50° FOV; color fundus image; 1924 by 1556 pixels:
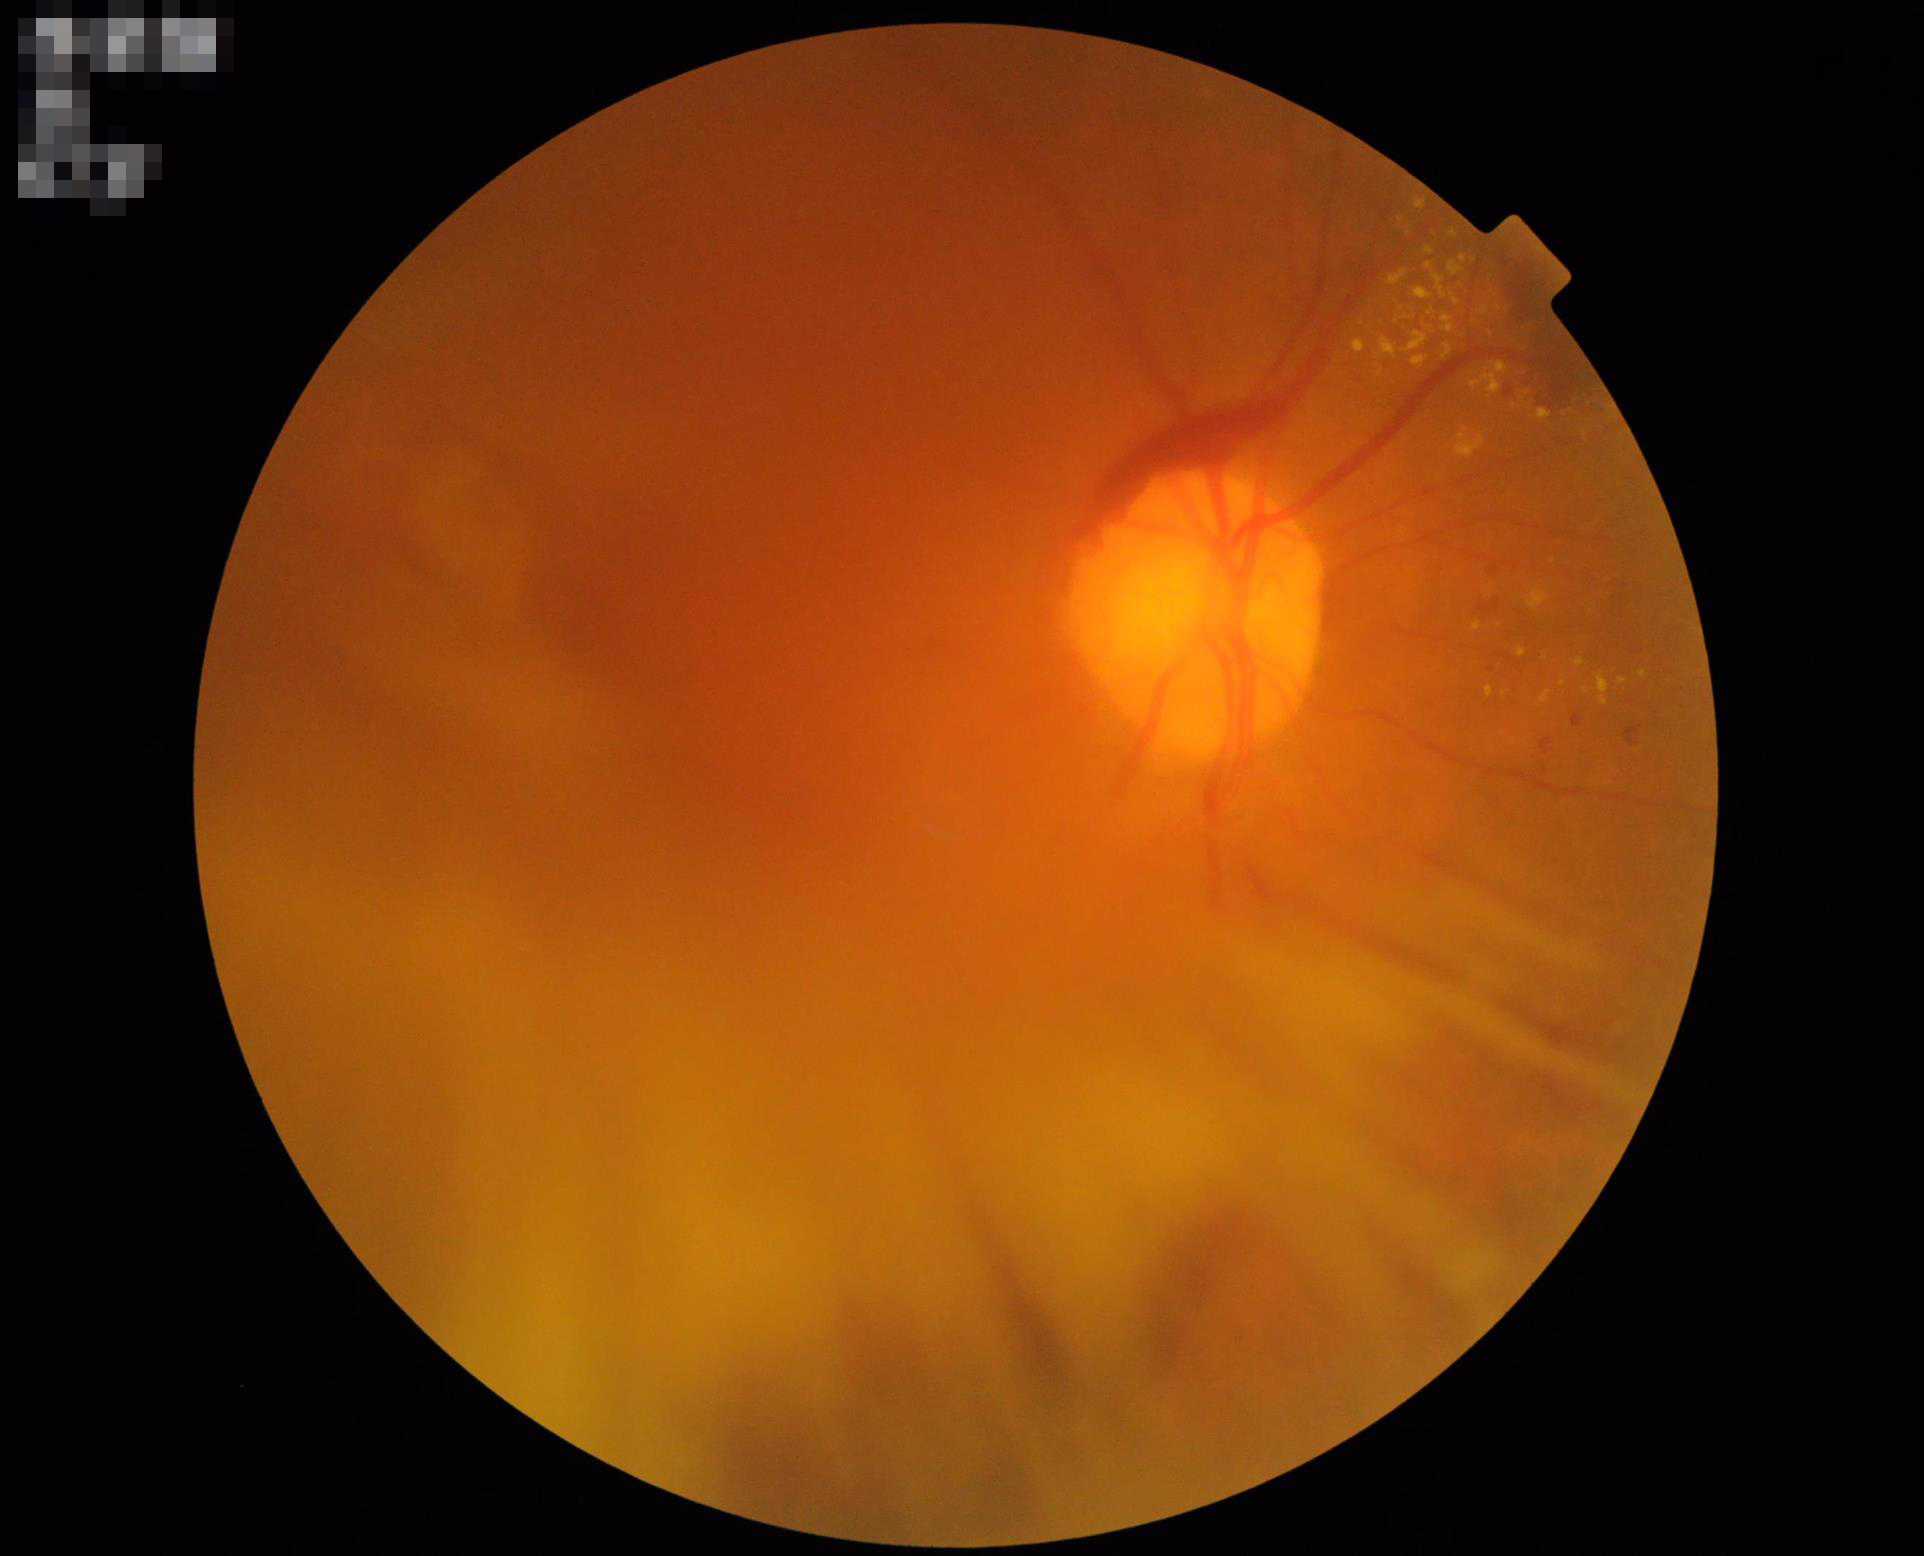 Quality assessment: overall: inadequate for clinical interpretation; illumination: good illumination and color balance; clarity: out of focus, structures indistinct.